45° field of view.
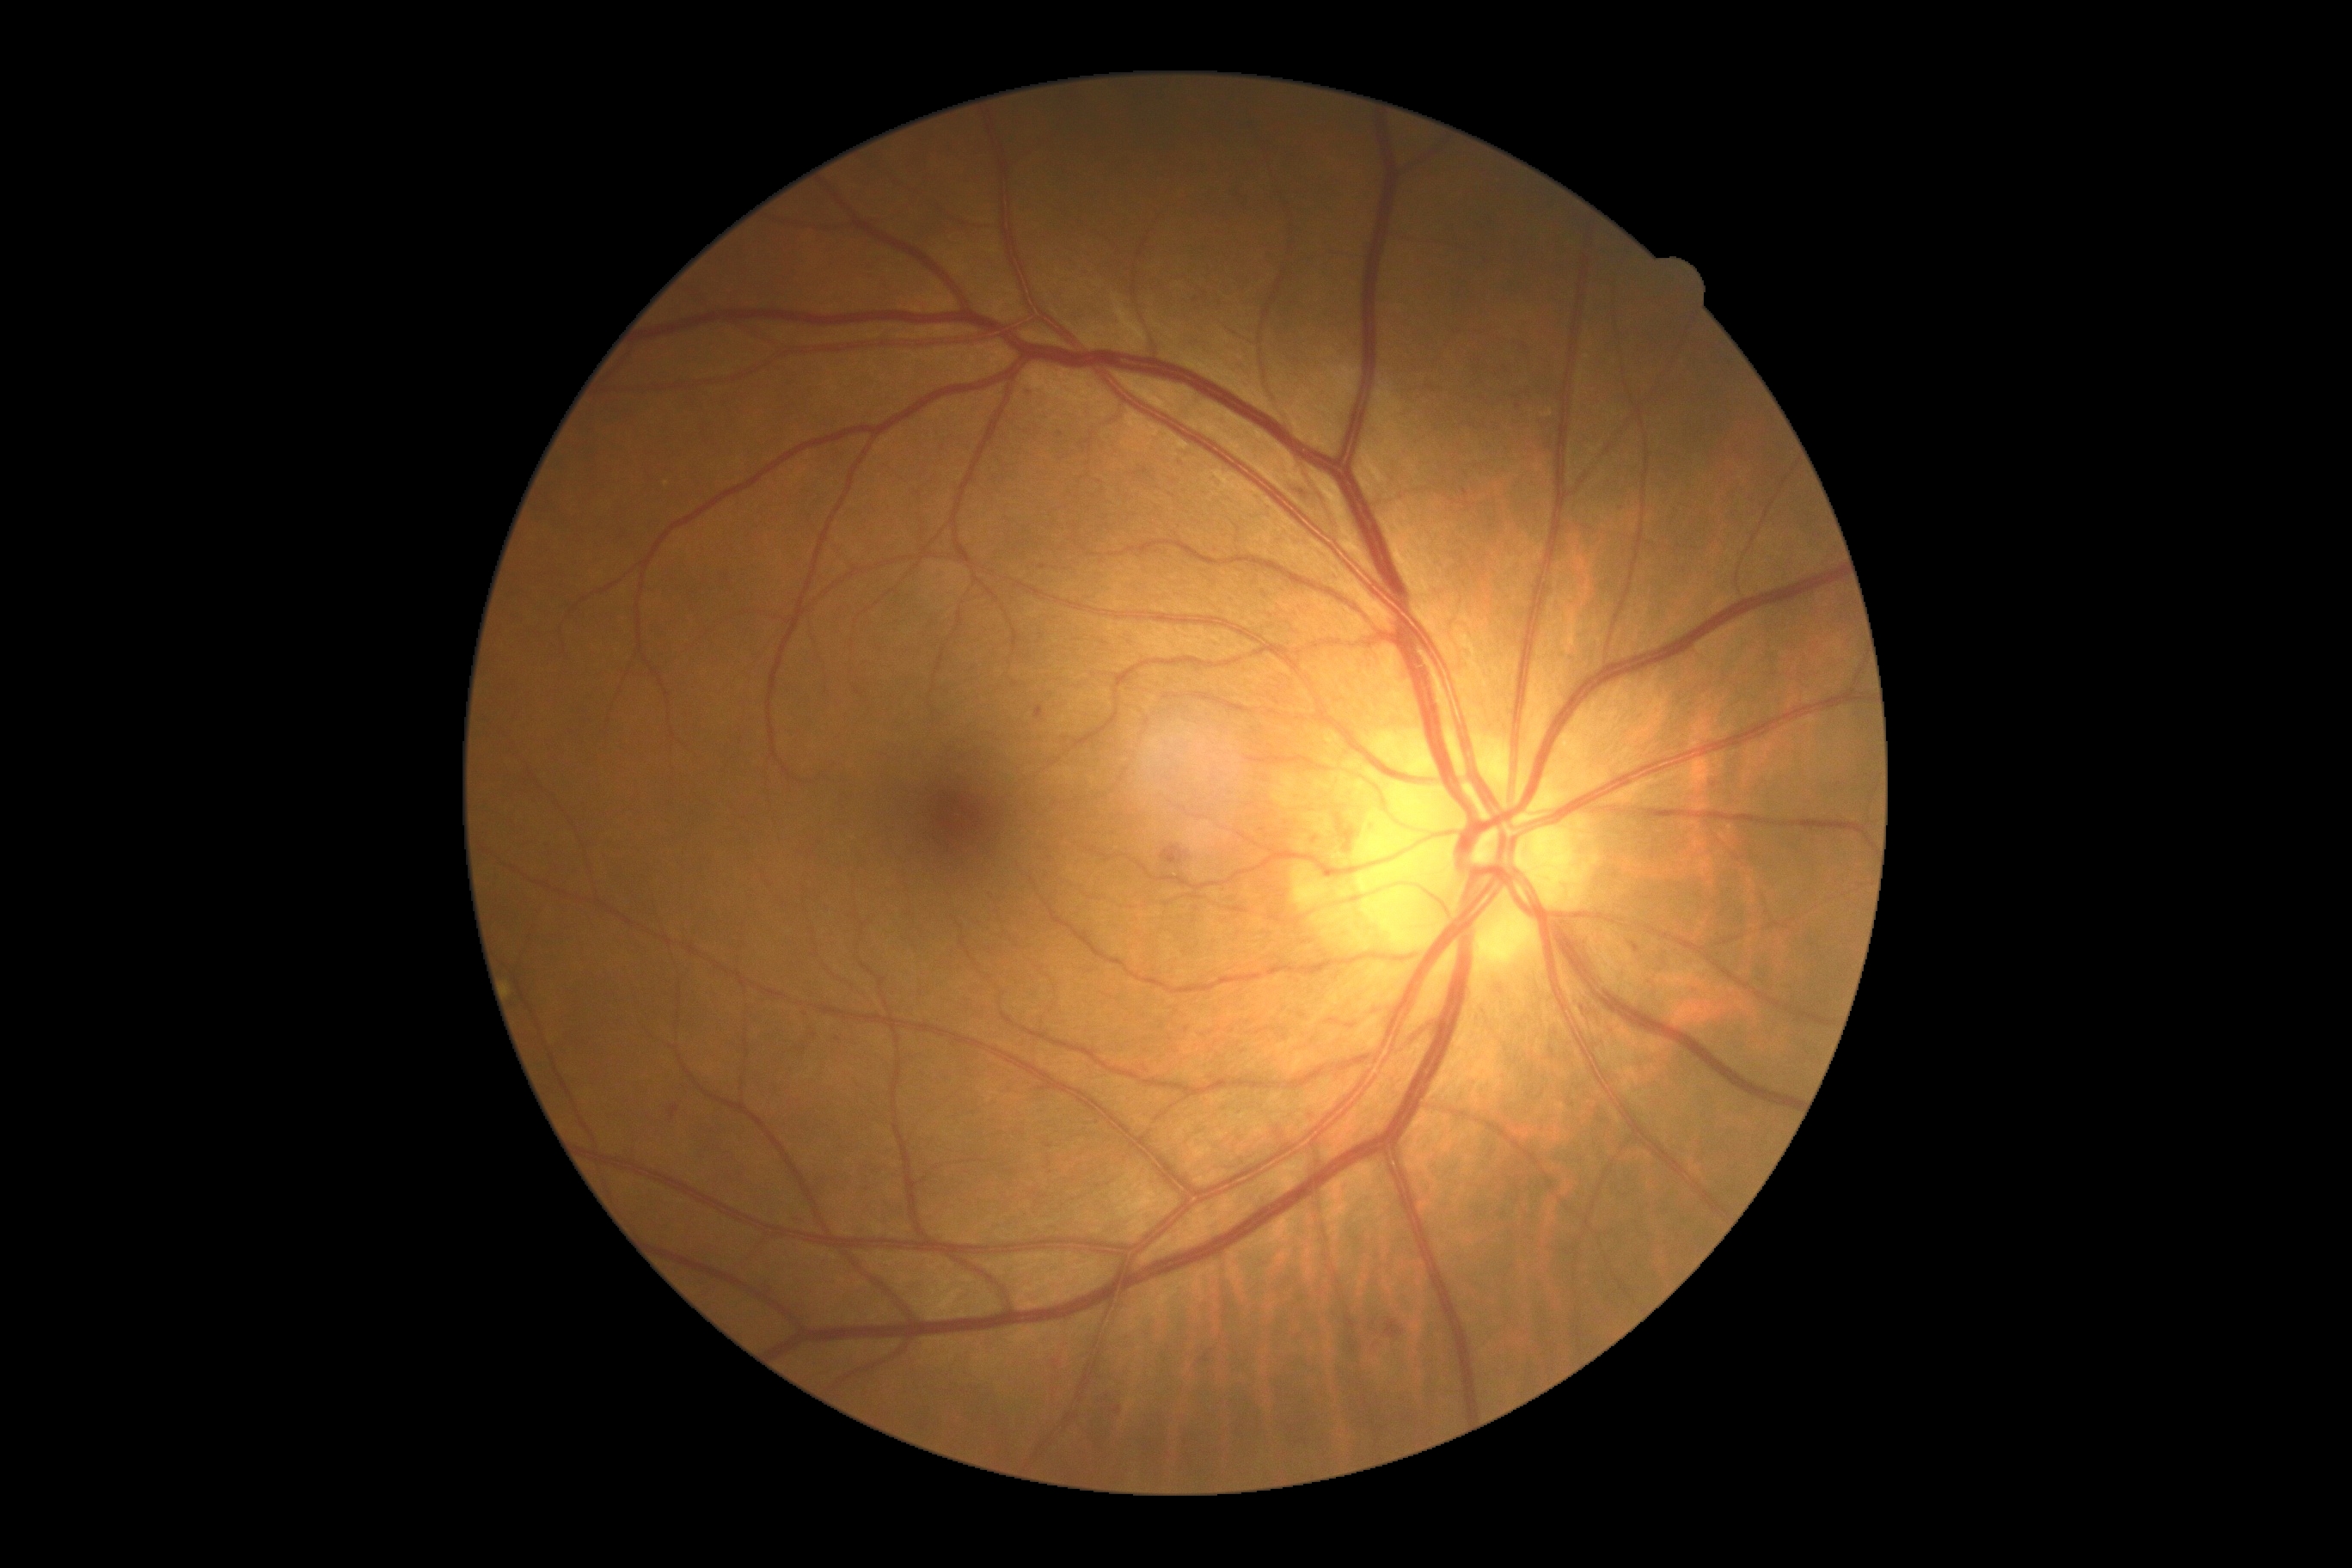
Findings:
- diabetic retinopathy (DR): 2/4 — more than just microaneurysms but less than severe NPDR
- DR class: non-proliferative diabetic retinopathy